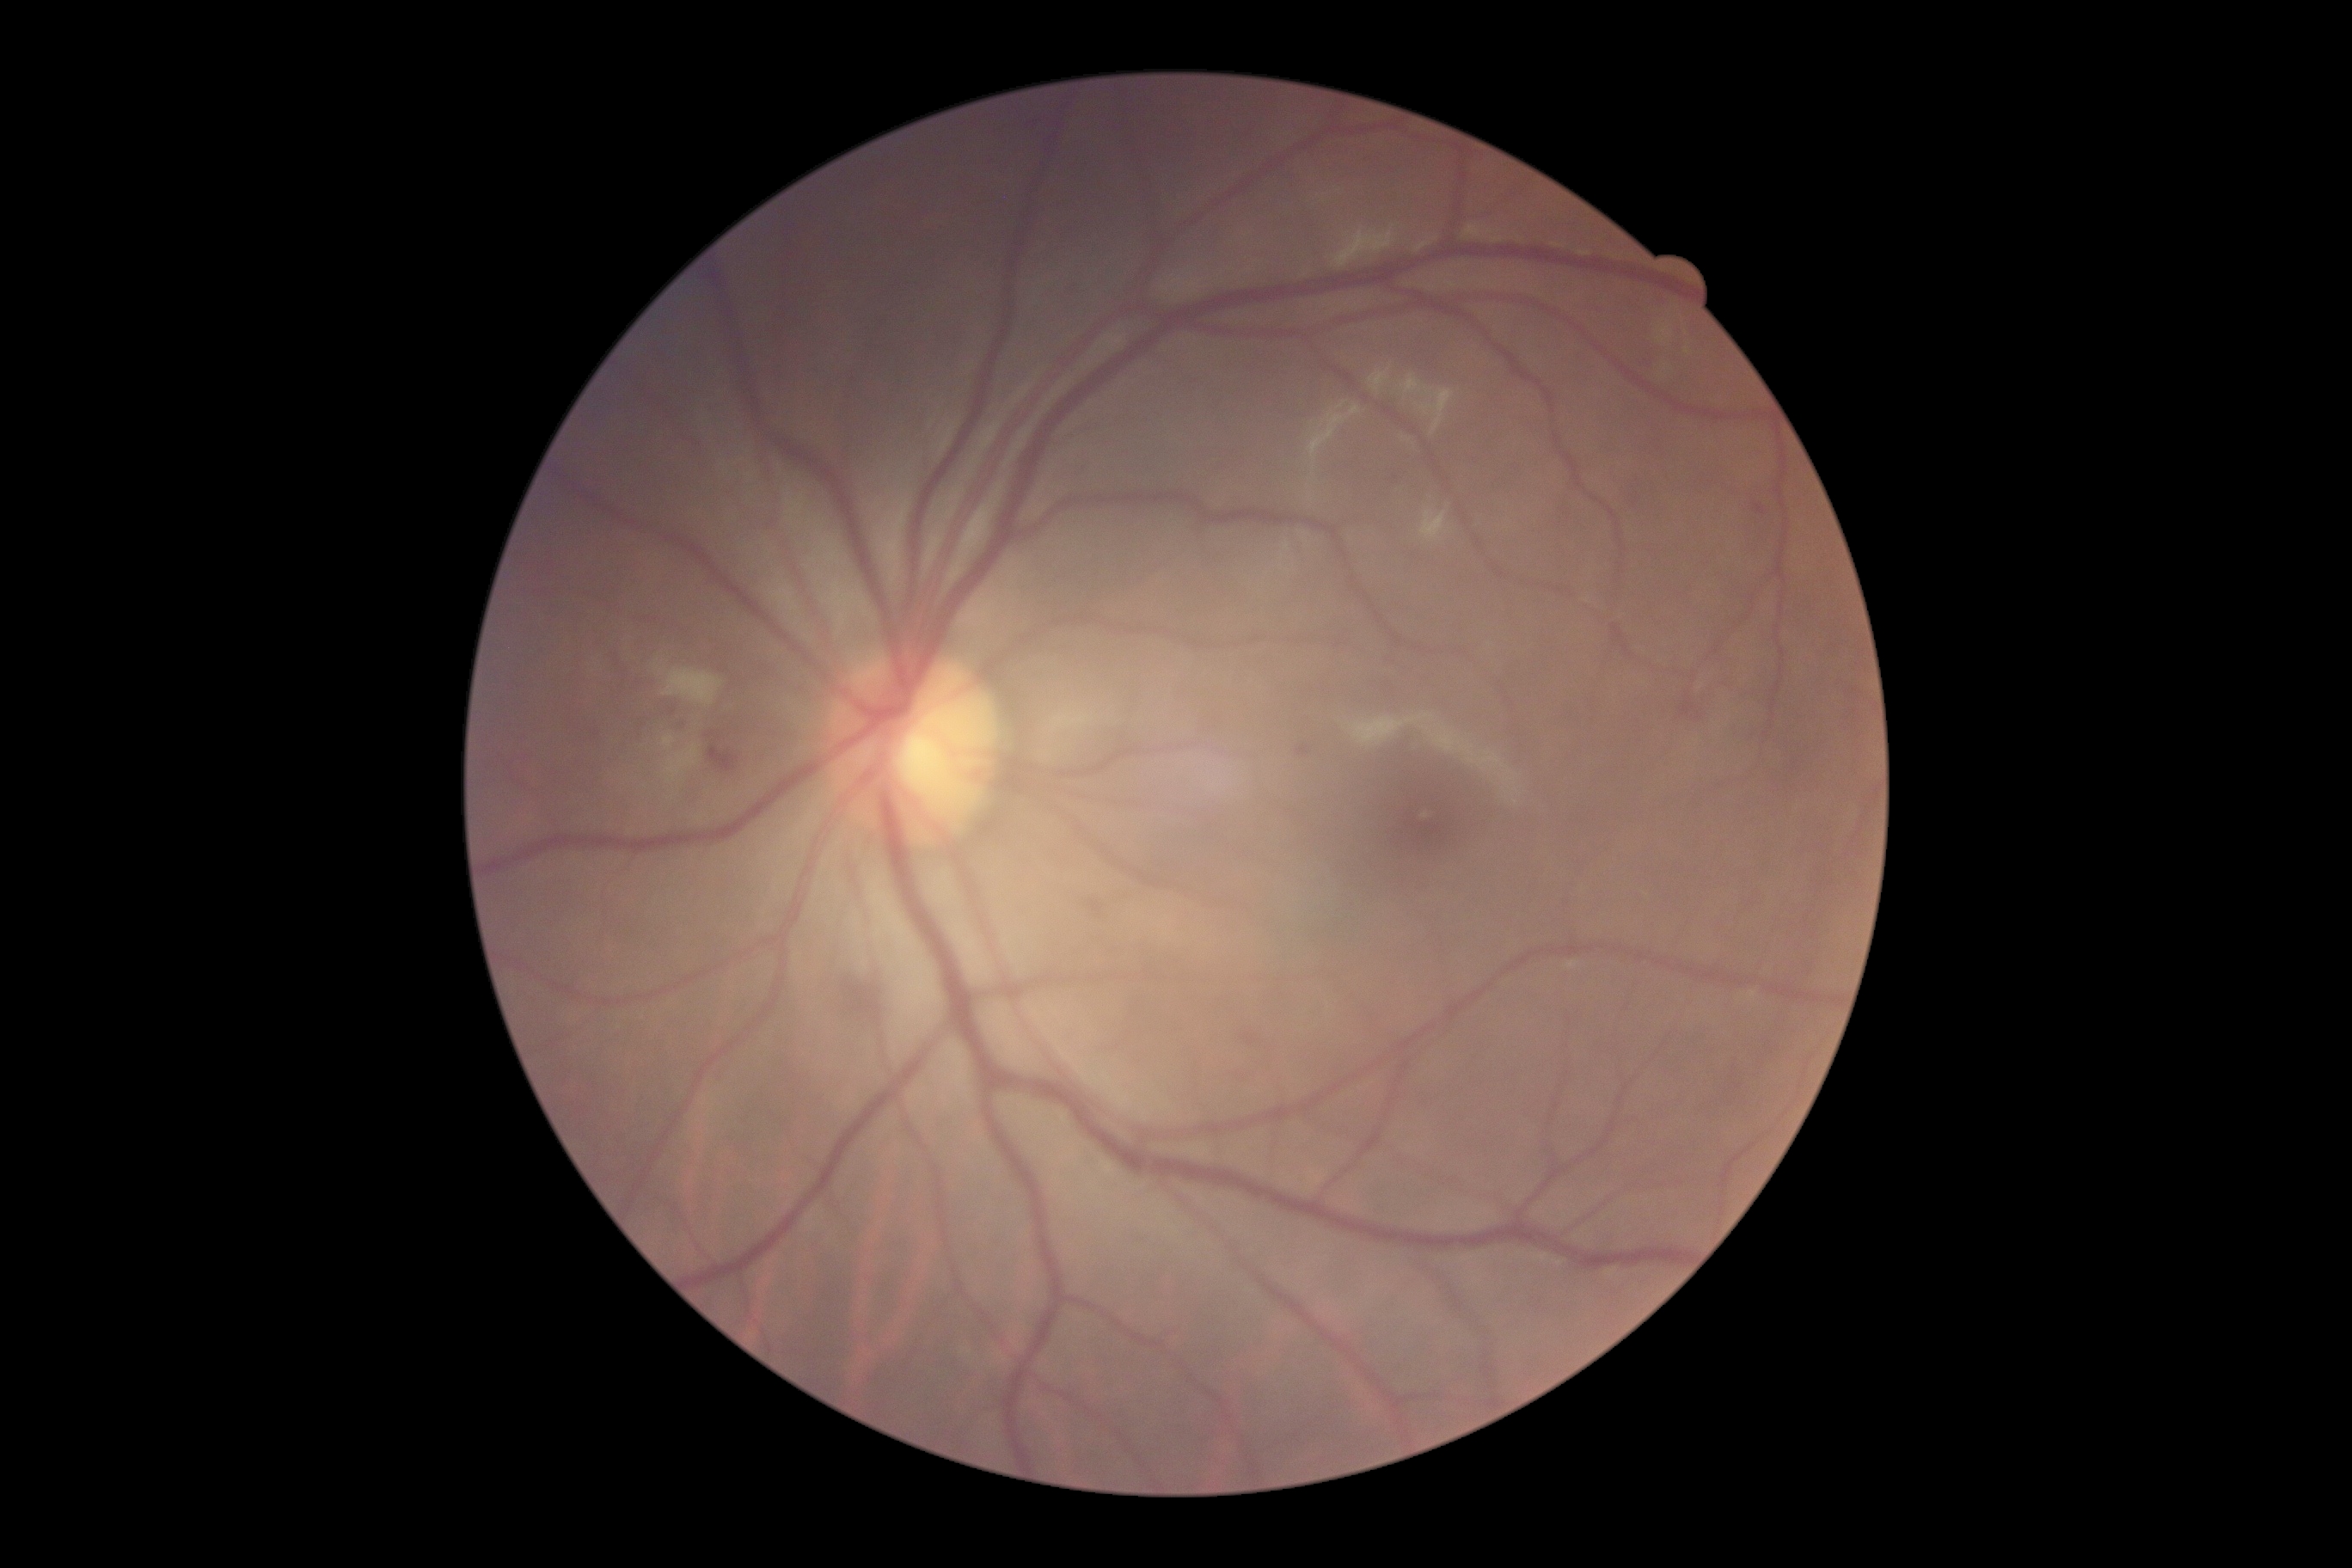
Diabetic retinopathy severity: grade 2 (moderate NPDR).